45-degree field of view; 2346 by 1568 pixels:
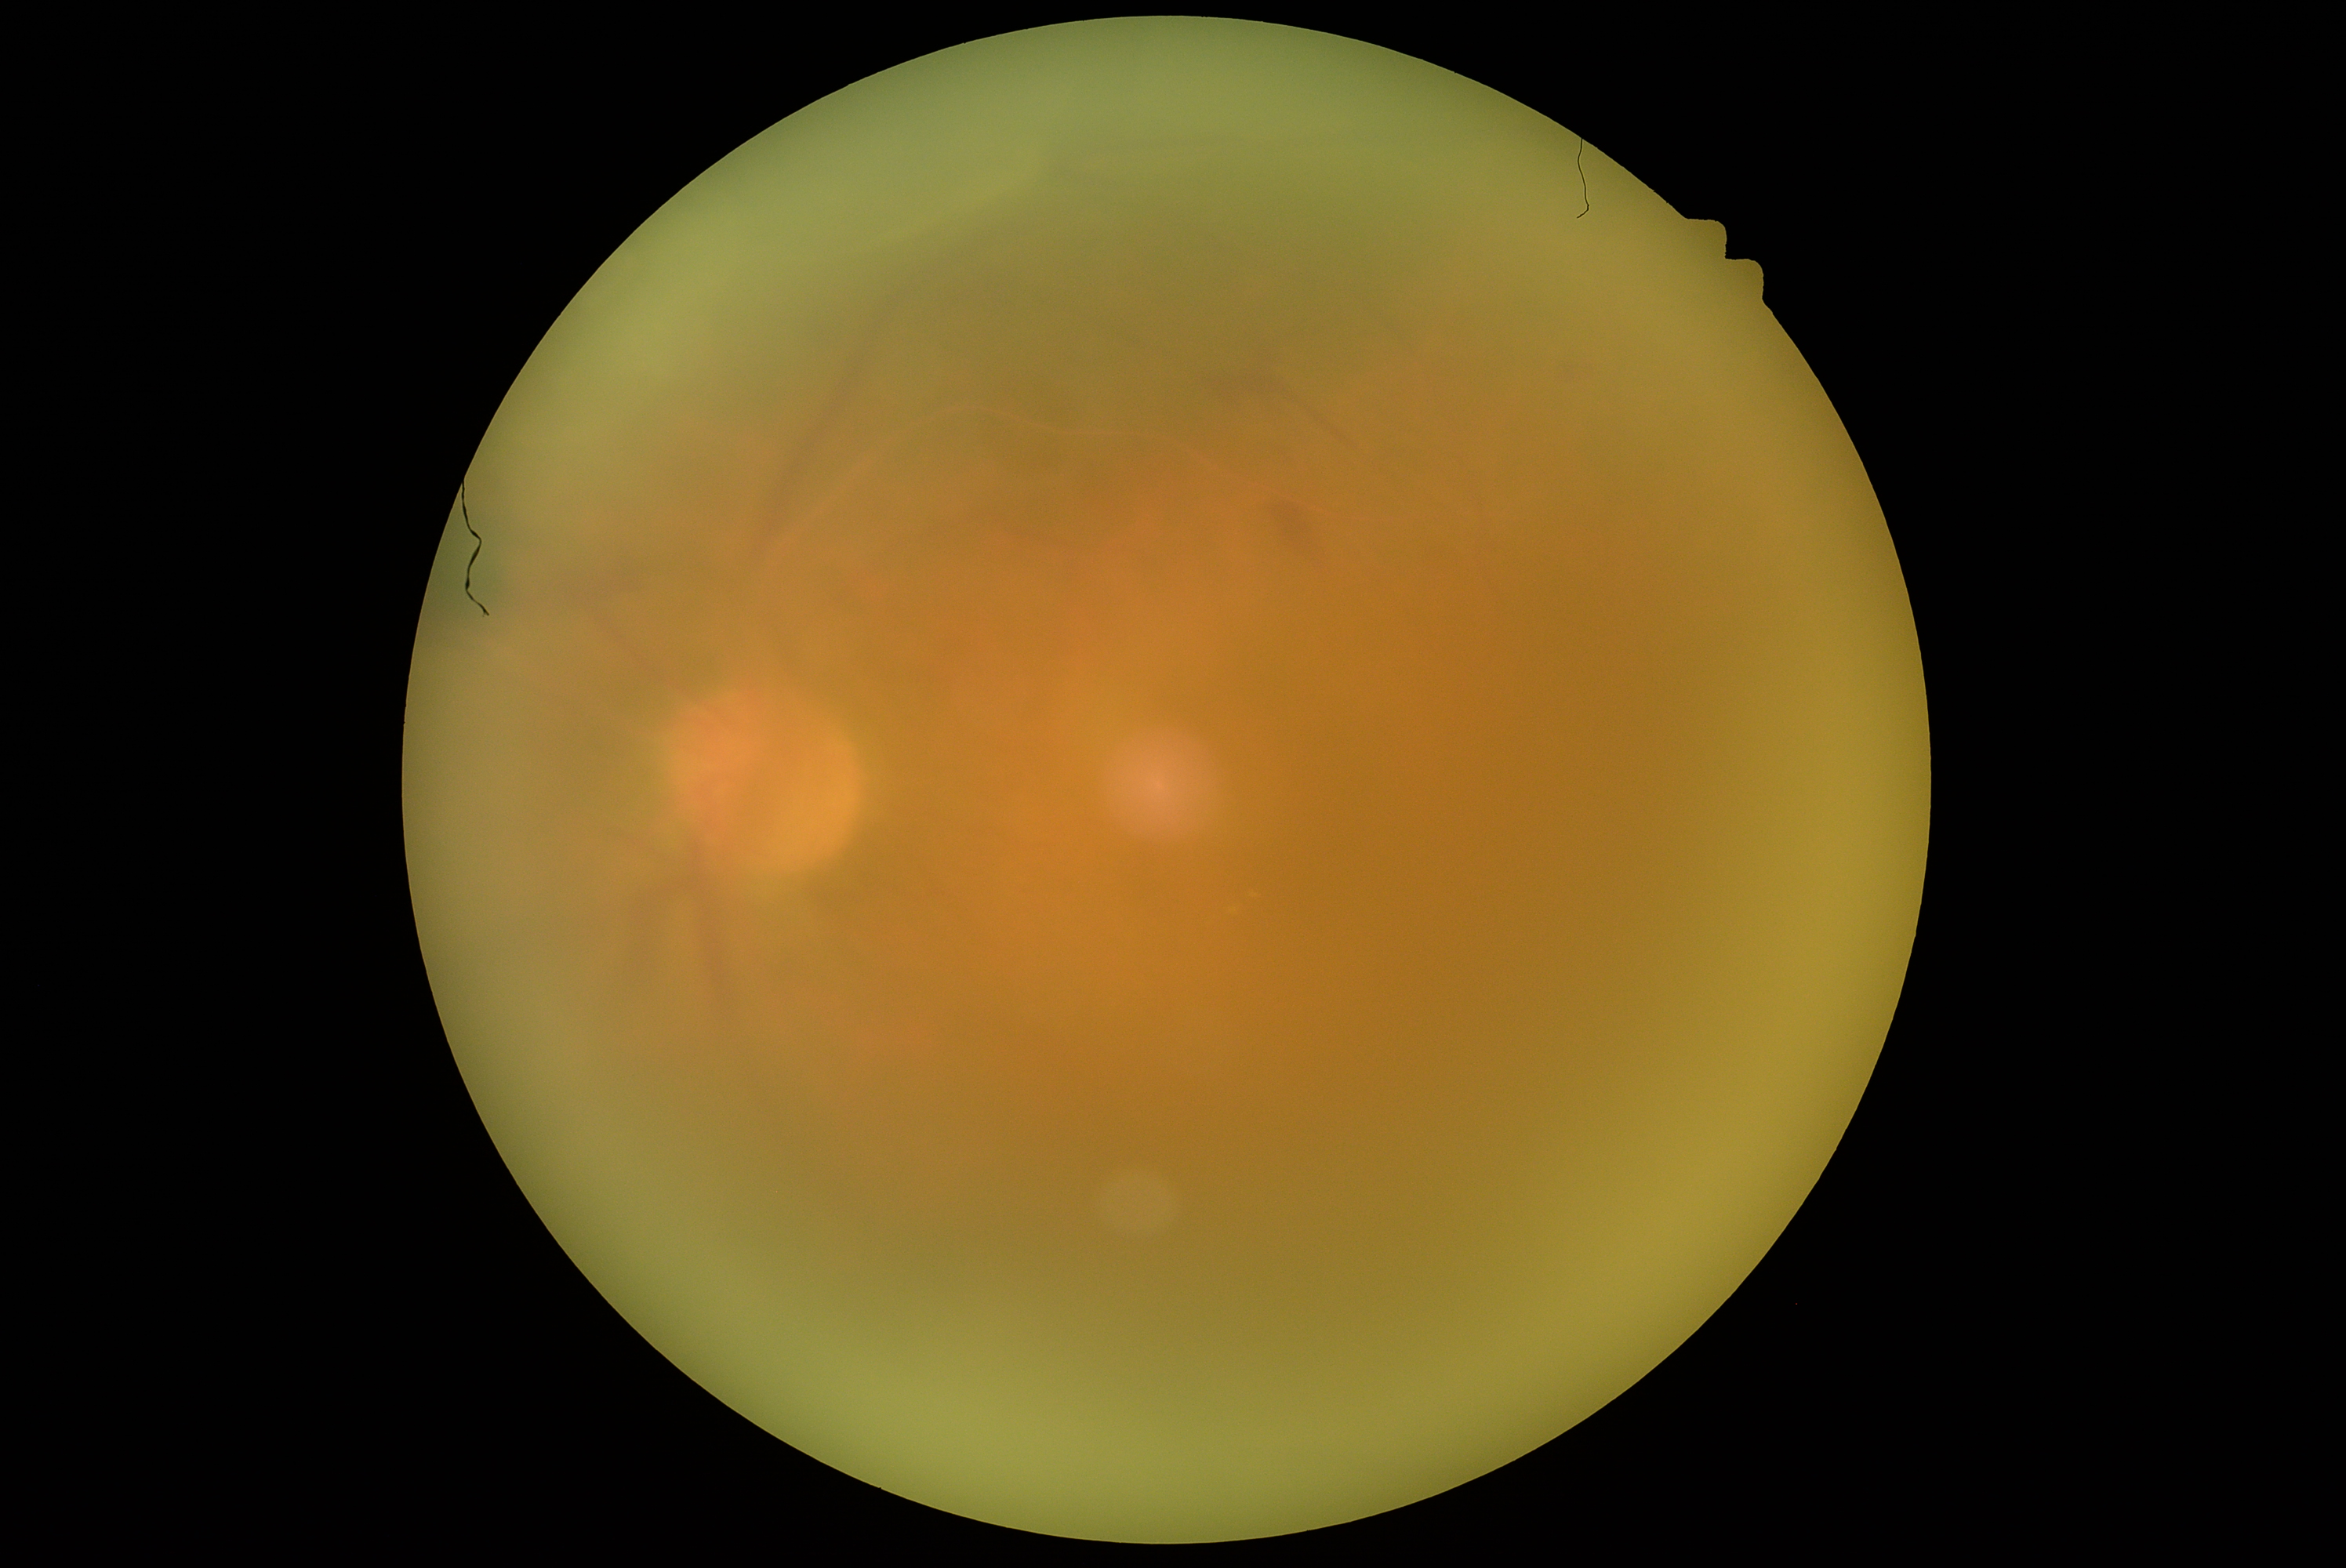 {"dr_grade": "2/4 — more than just microaneurysms but less than severe NPDR"}